1440 x 1080 pixels. Acquired on the Natus RetCam Envision. Wide-field fundus image from infant ROP screening — 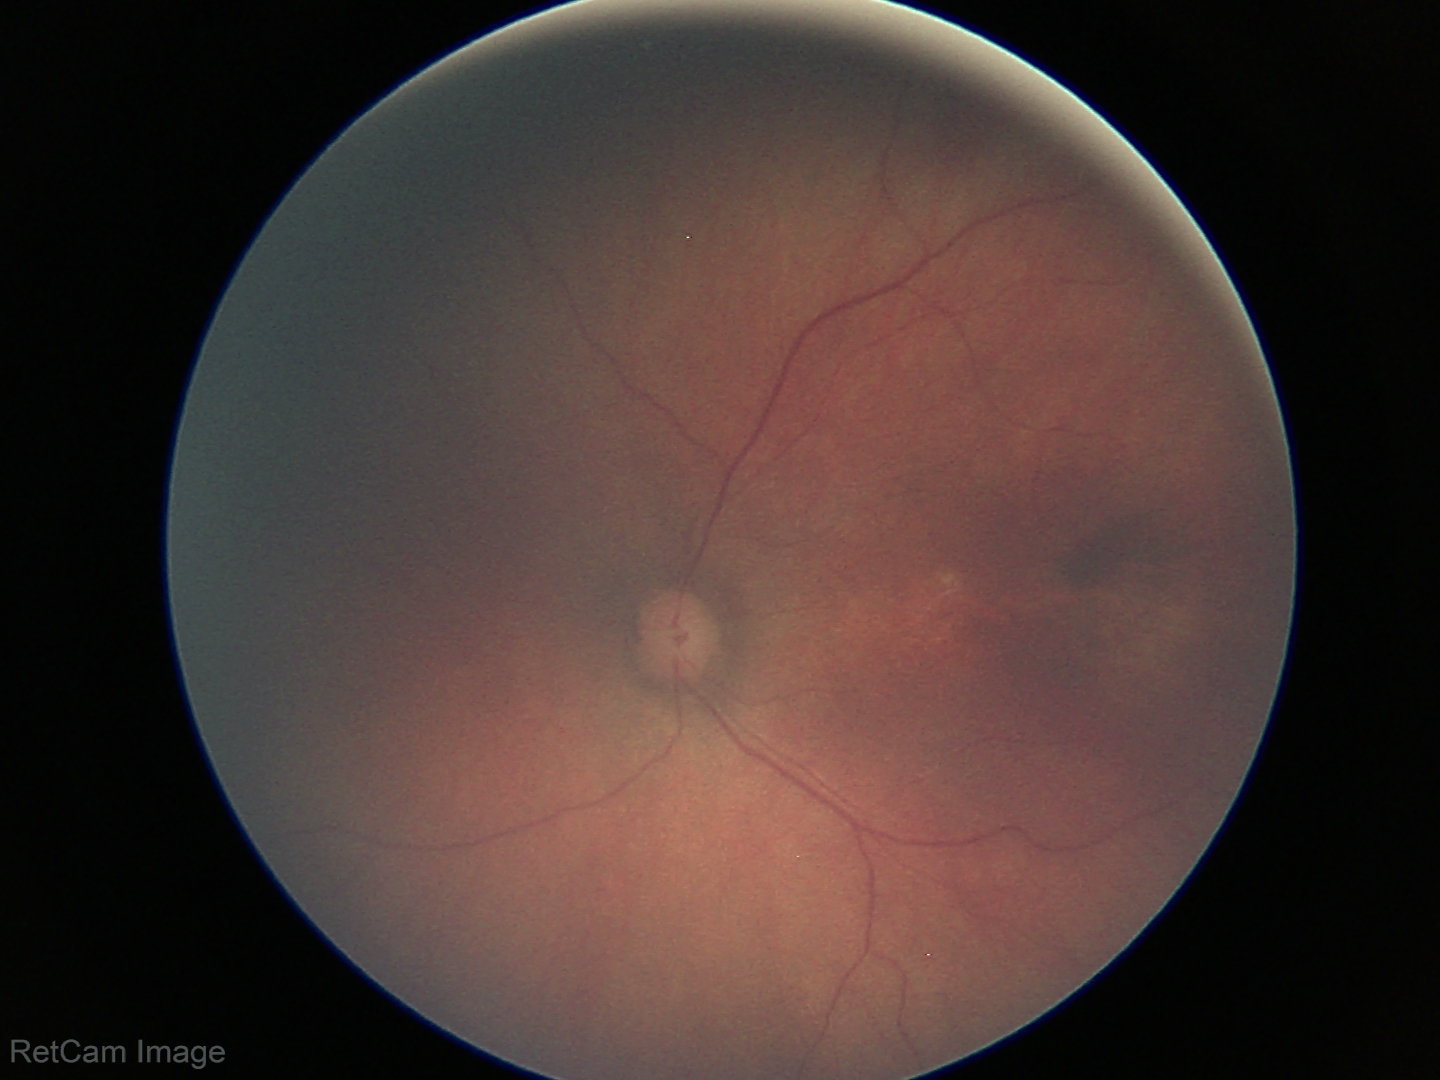
Screening examination diagnosed as physiological.